240x240px, CFP.
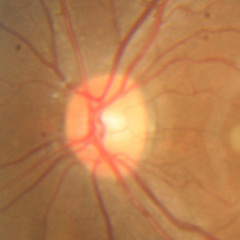
Q: Is glaucoma present?
A: No — no glaucoma.